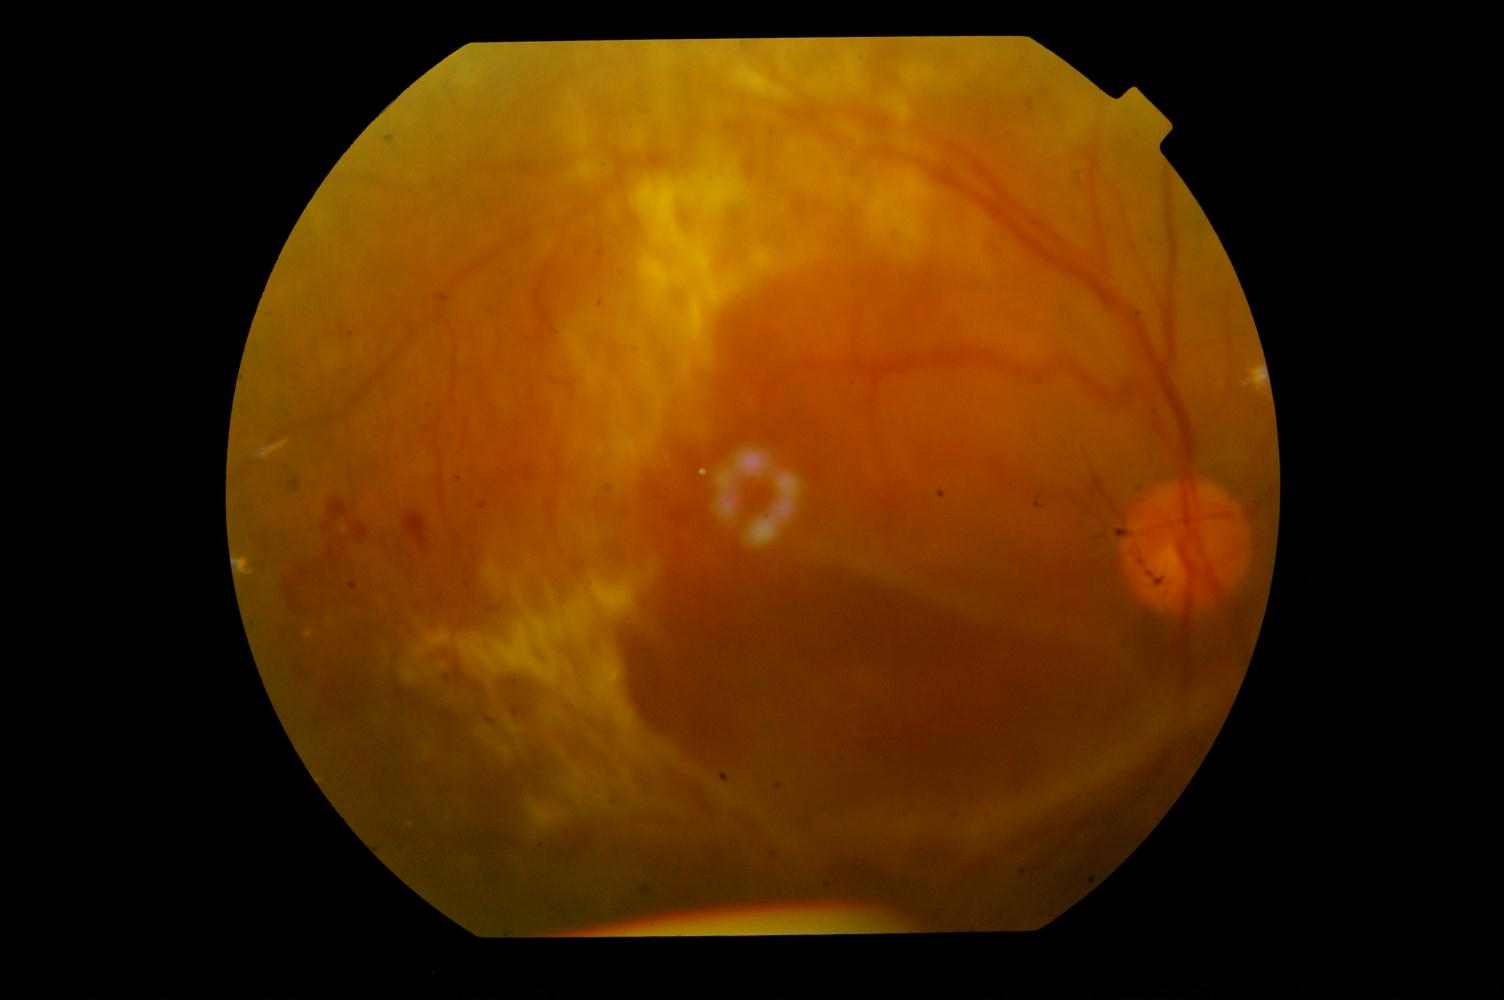
Color fundus photograph showing DR (diabetic retinopathy).